RetCam wide-field infant fundus image; Clarity RetCam 3, 130° FOV
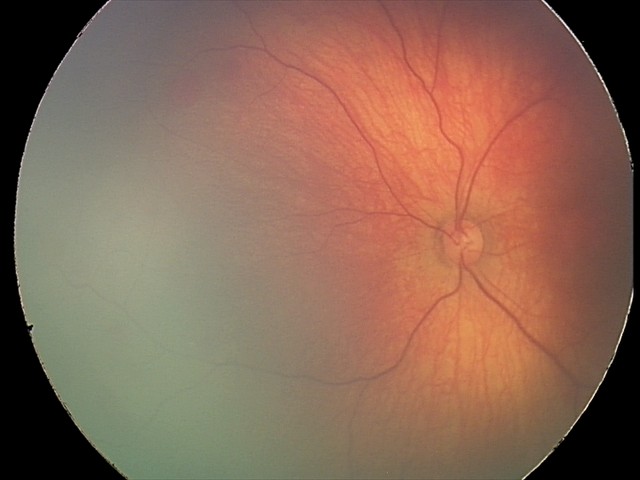

Examination diagnosed as retinal hemorrhages.